2089 x 1764 pixels:
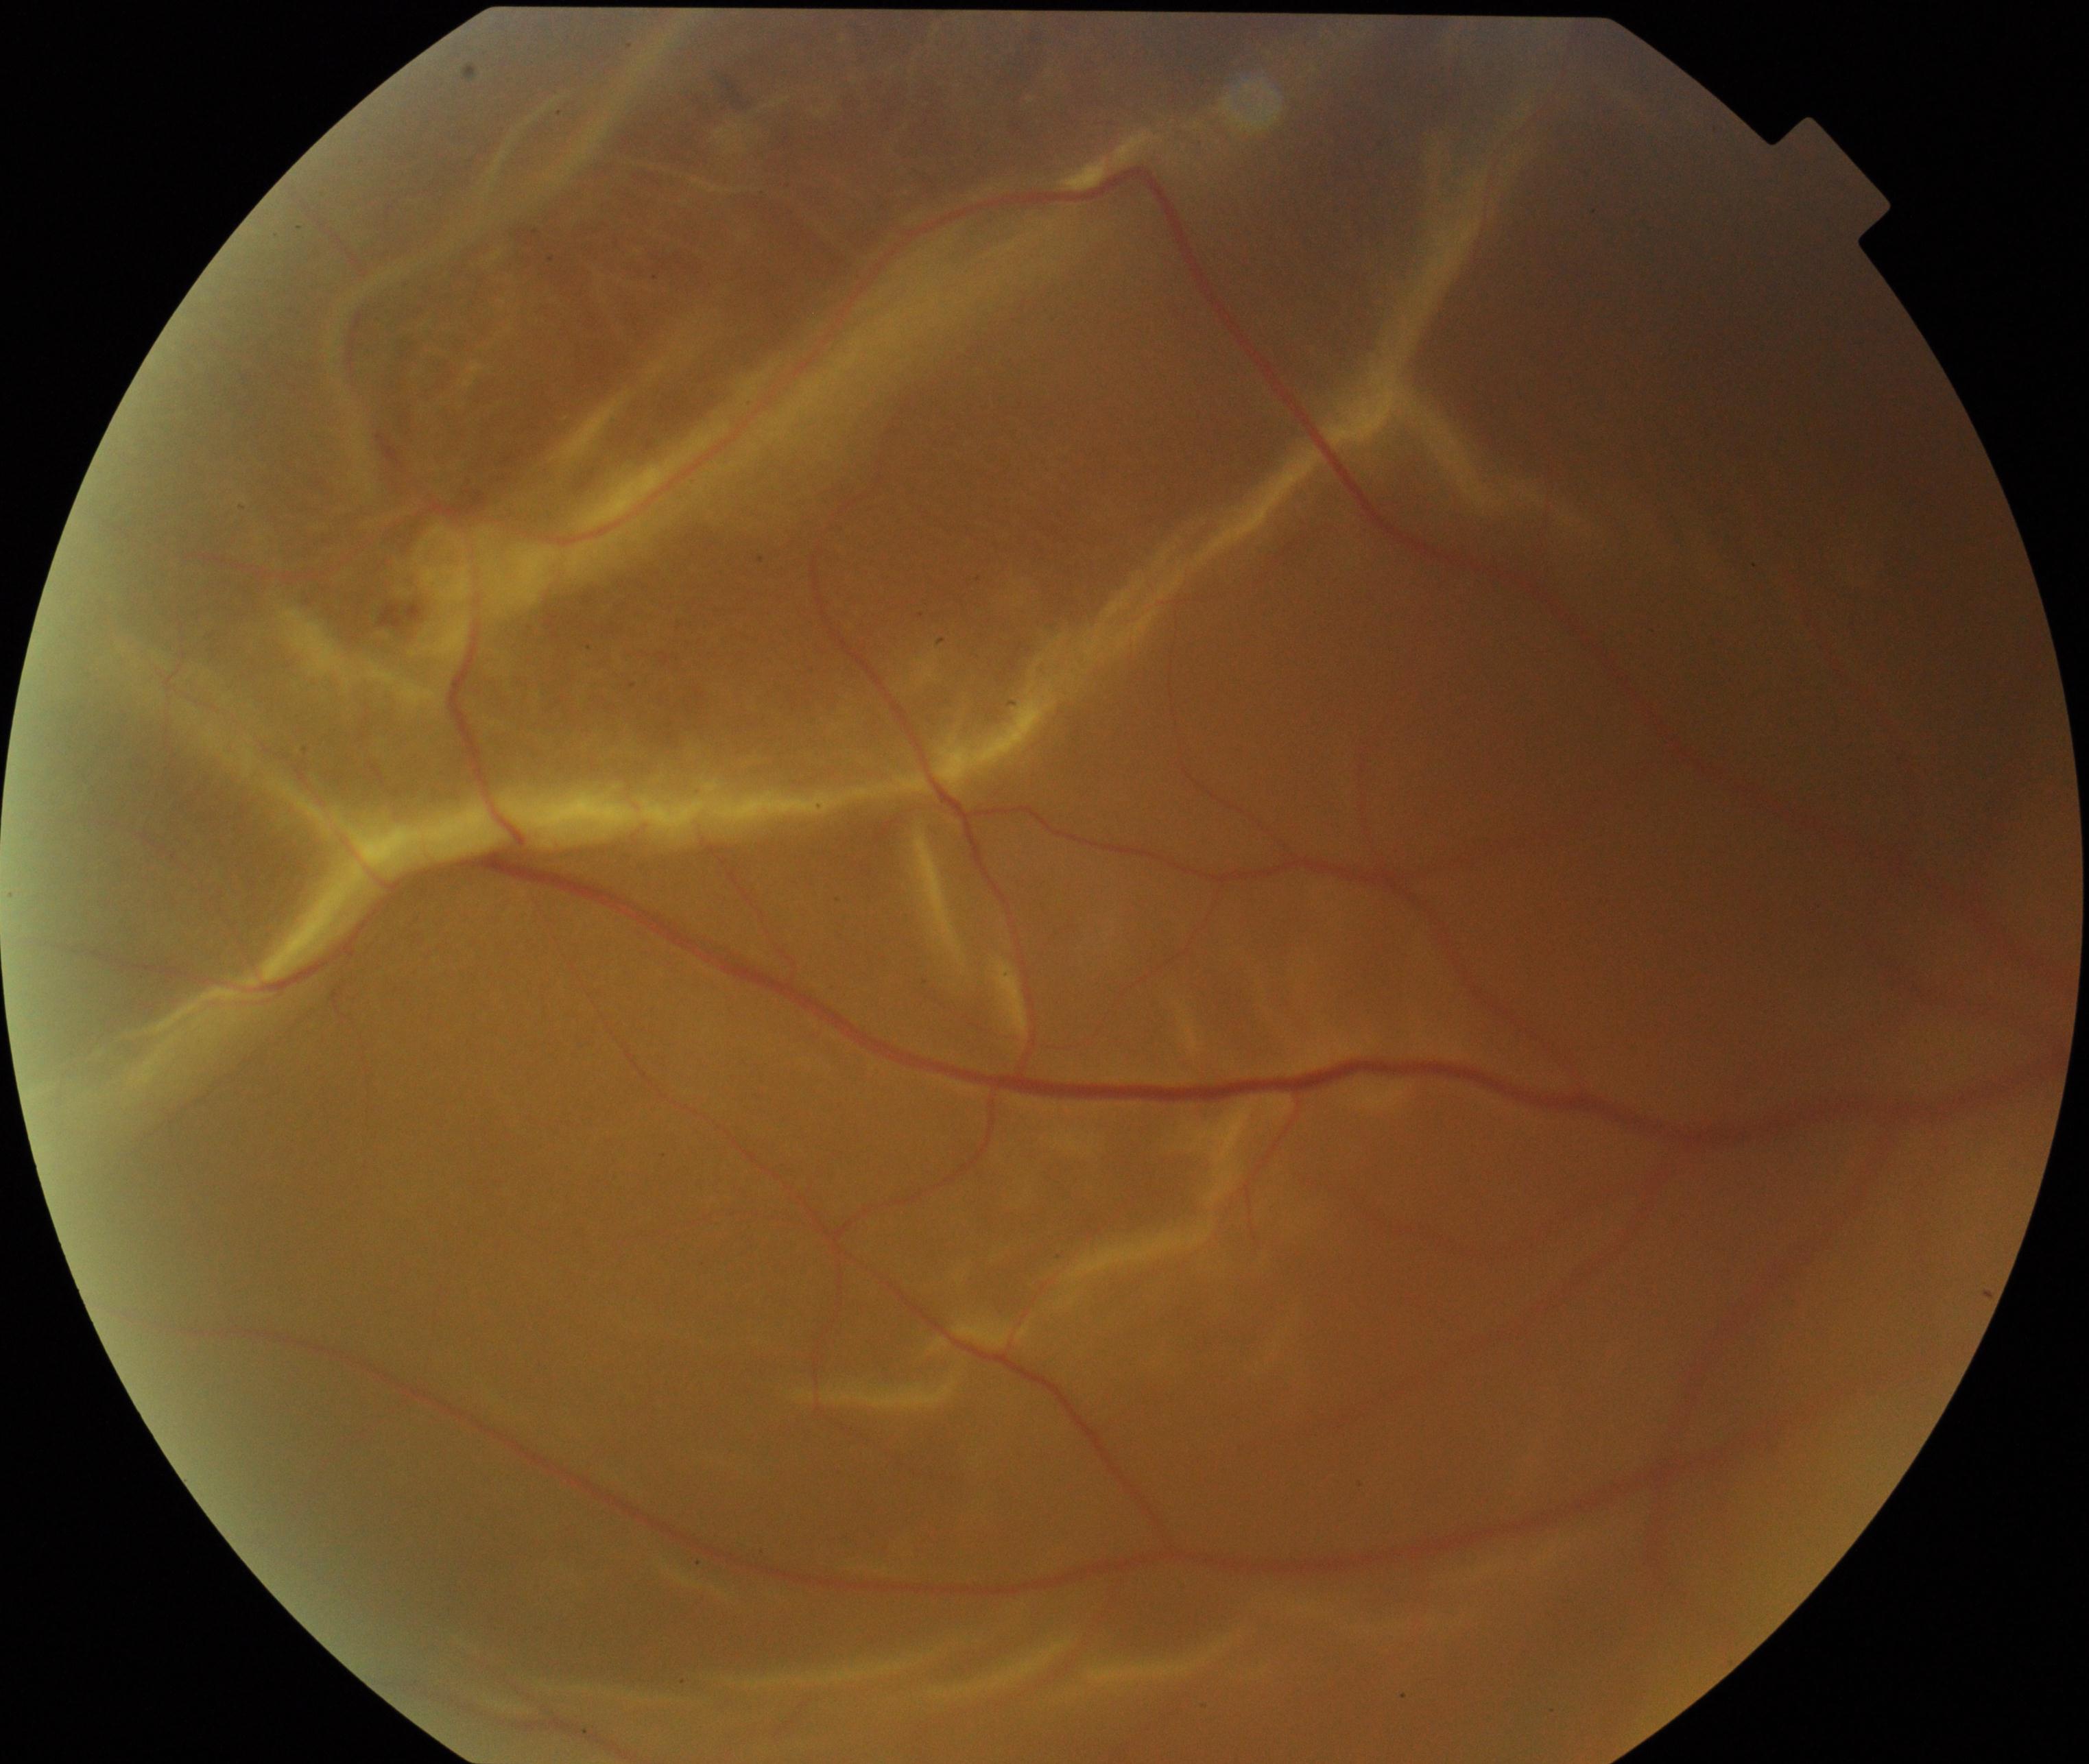 There is evidence of rhegmatogenous retinal detachment.